Camera: NIDEK AFC-230: 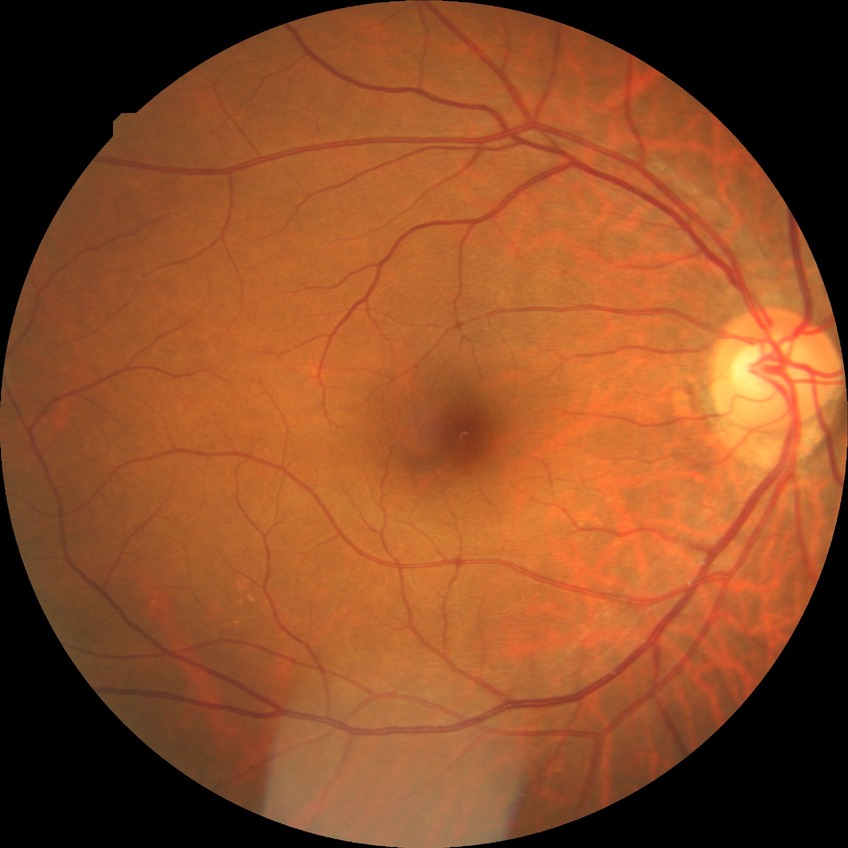

Davis stage: NDR.